Modified Davis classification, NIDEK AFC-230, without pupil dilation, FOV: 45 degrees, image size 848x848
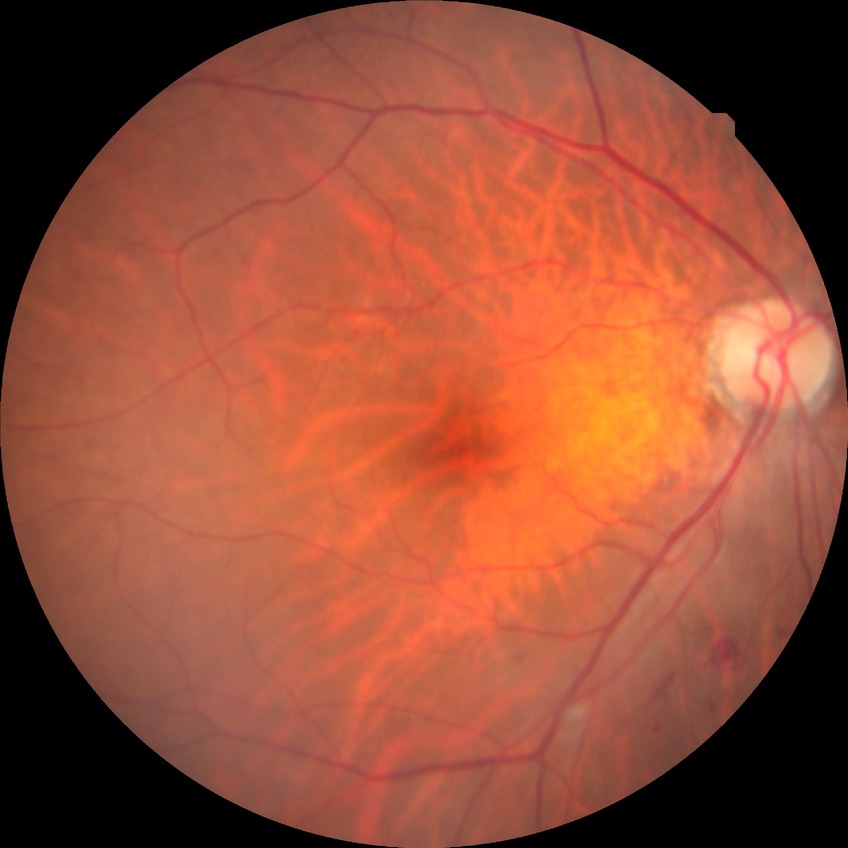
DR grade: SDR.